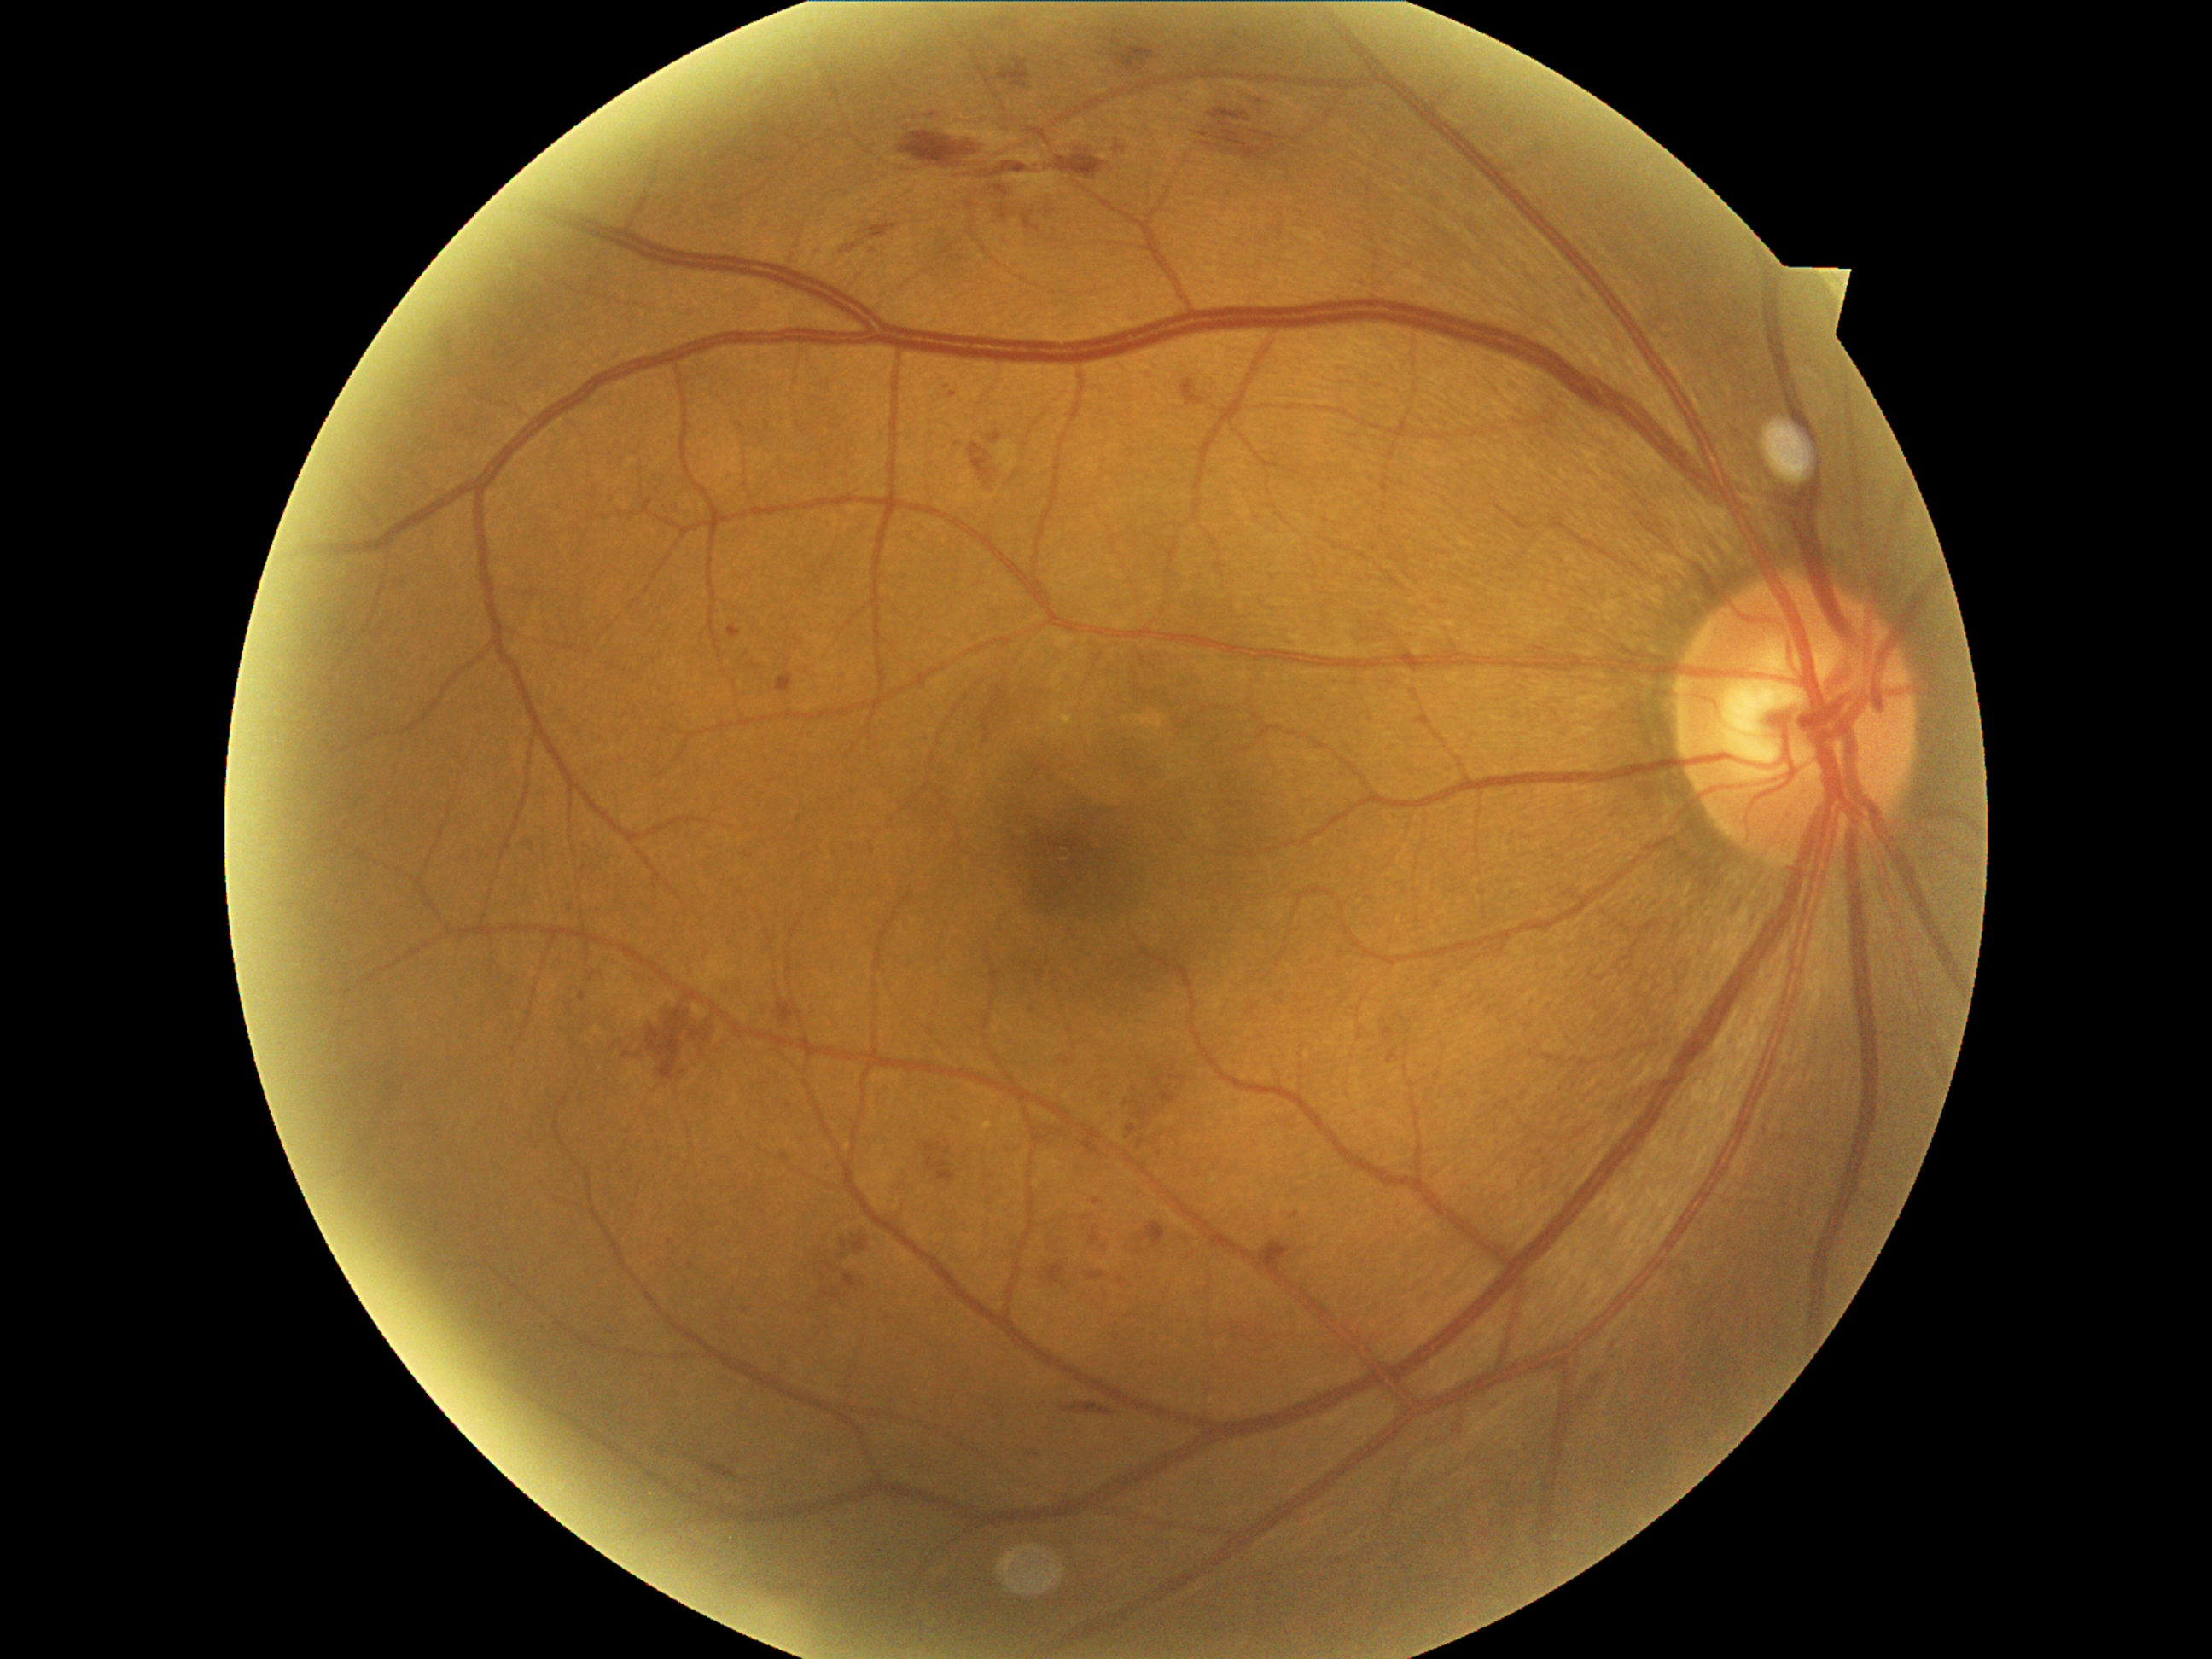

Diabetic retinopathy (DR): grade 2 — more than just microaneurysms but less than severe NPDR
Representative lesions:
hemorrhages (HEs) (continued): box=[1155, 1074, 1167, 1086] | box=[1201, 132, 1209, 139] | box=[1107, 38, 1163, 76] | box=[979, 149, 1103, 180] | box=[1383, 1027, 1397, 1039] | box=[996, 204, 1016, 224] | box=[1115, 146, 1126, 154] | box=[822, 1288, 841, 1301] | box=[1032, 760, 1051, 777] | box=[844, 1272, 868, 1293] | box=[1387, 1049, 1399, 1064] | box=[1204, 143, 1214, 149] | box=[1061, 1400, 1119, 1417] | box=[996, 57, 1032, 90] | box=[707, 1464, 747, 1482]
HEs (small, approximate centers) near 1146:1098 | 1105:1249 | 1132:1159 | 1341:955